848x848, posterior pole color fundus photograph, without pupil dilation
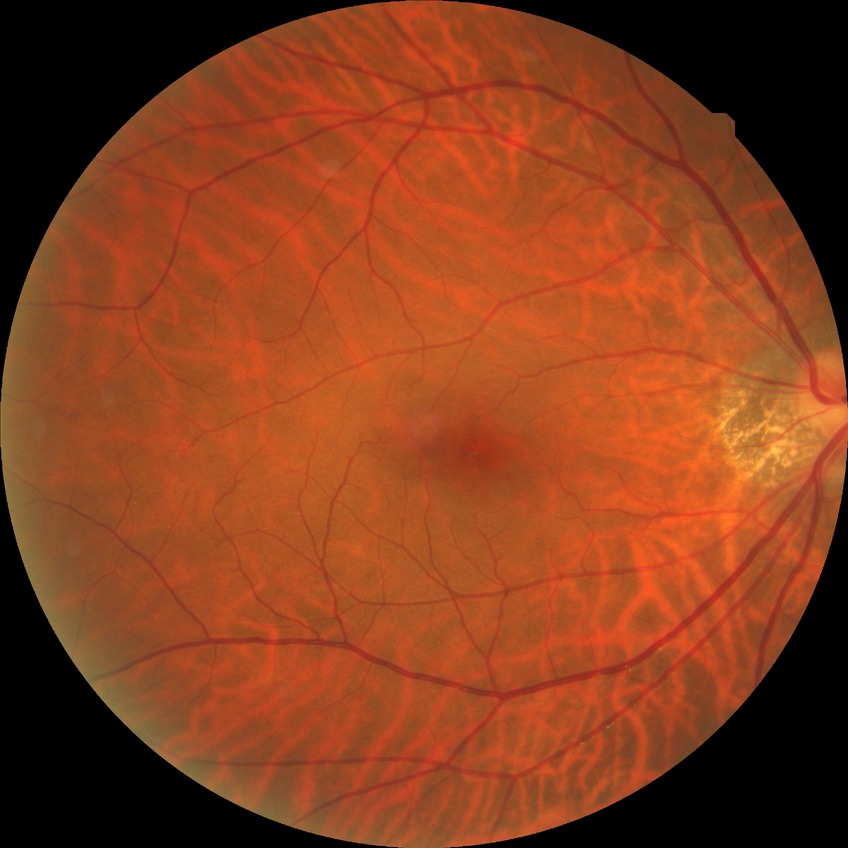

Davis stage: NDR.